Posterior pole color fundus photograph · 848 by 848 pixels · diabetic retinopathy graded by the modified Davis classification · NIDEK AFC-230 fundus camera
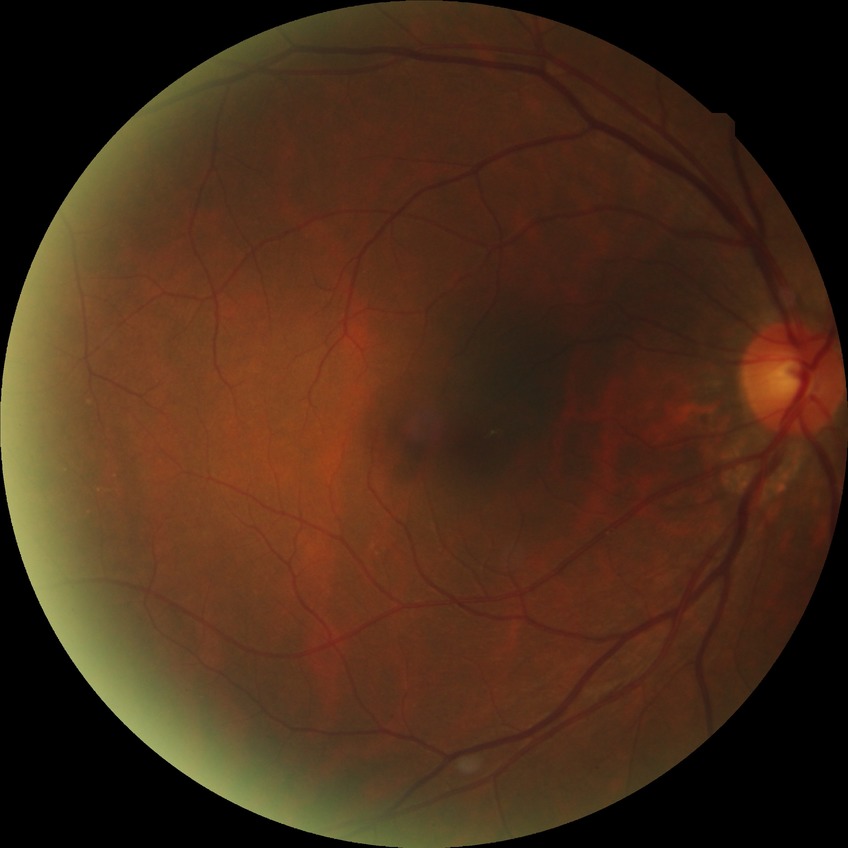
Diabetic retinopathy (DR): NDR (no diabetic retinopathy).